Wide-field fundus photograph of an infant: 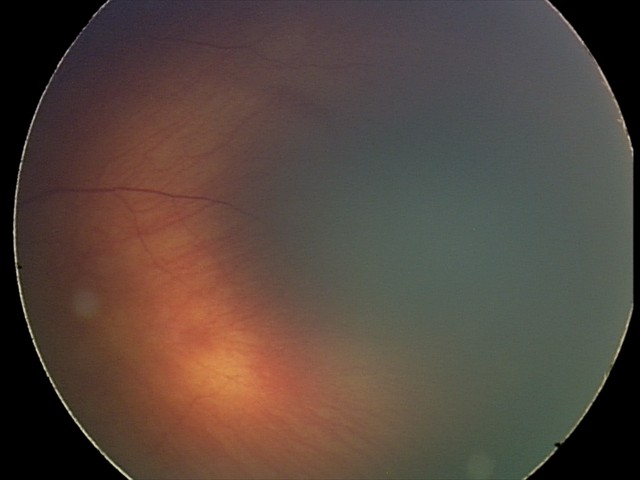 Examination diagnosed as retinal hemorrhages.